45° FOV.
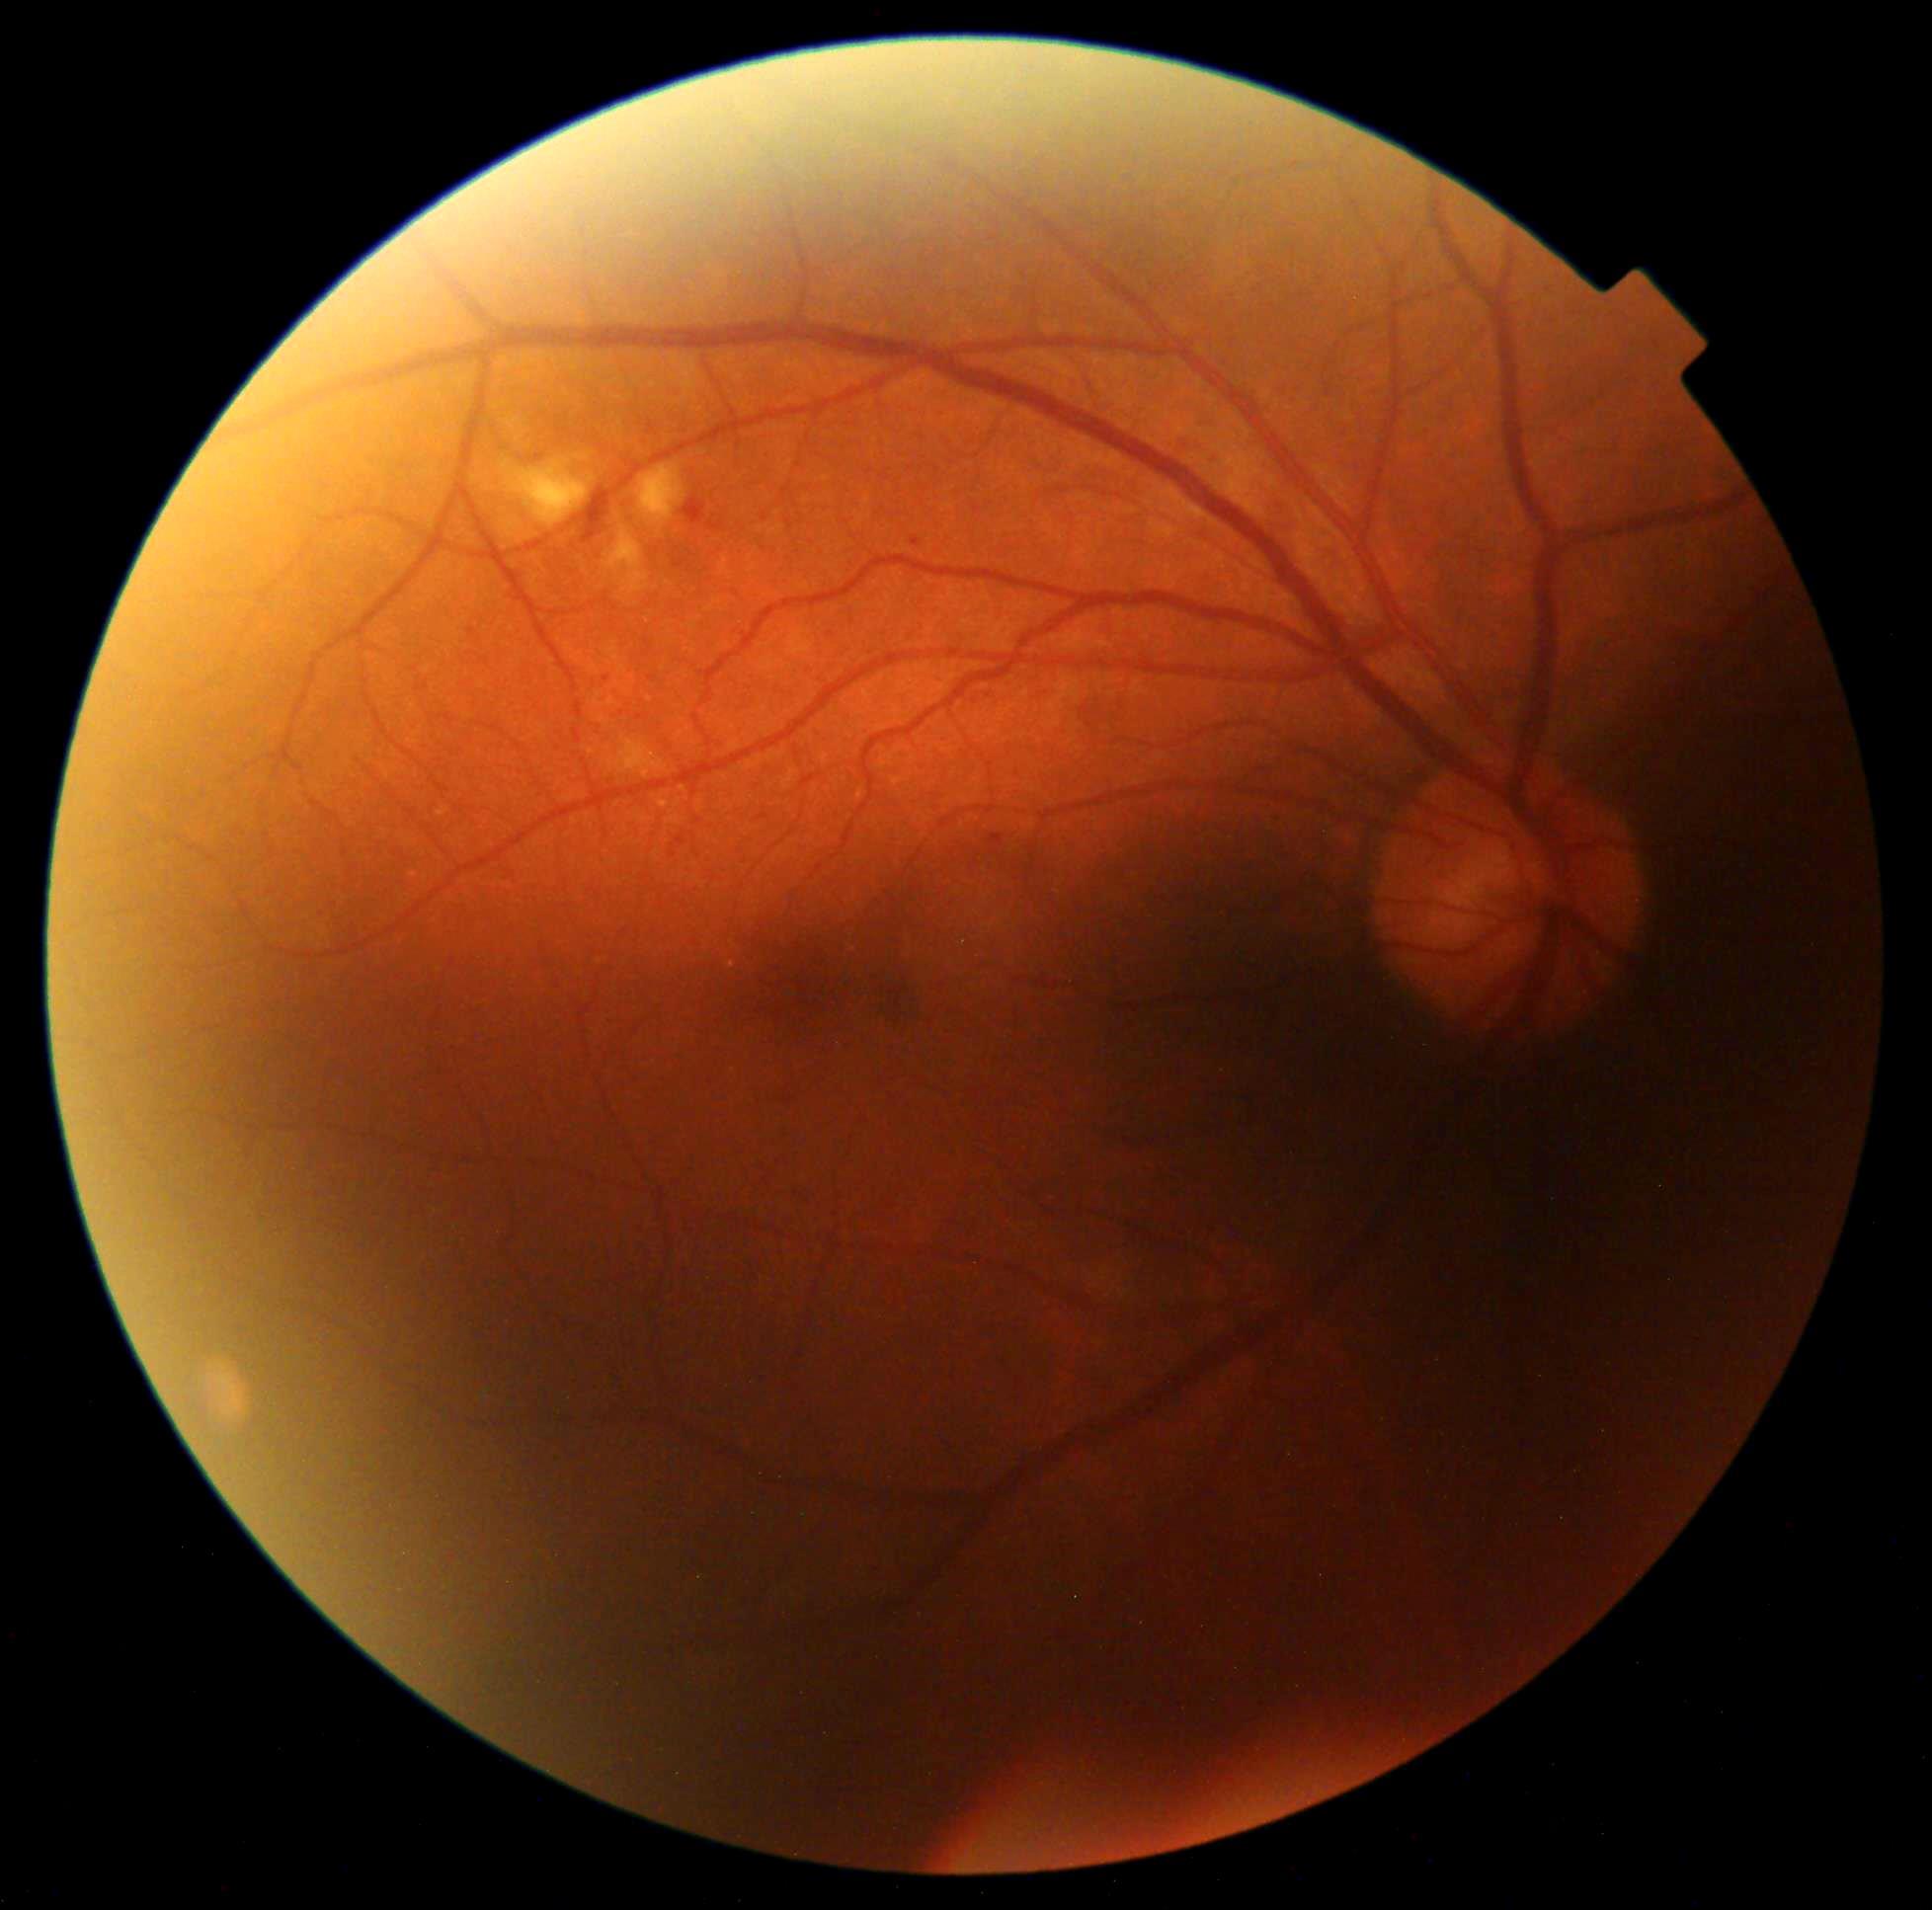

DR severity: grade 2 (moderate NPDR).